Image size 1240x1240; wide-field fundus photograph of an infant — 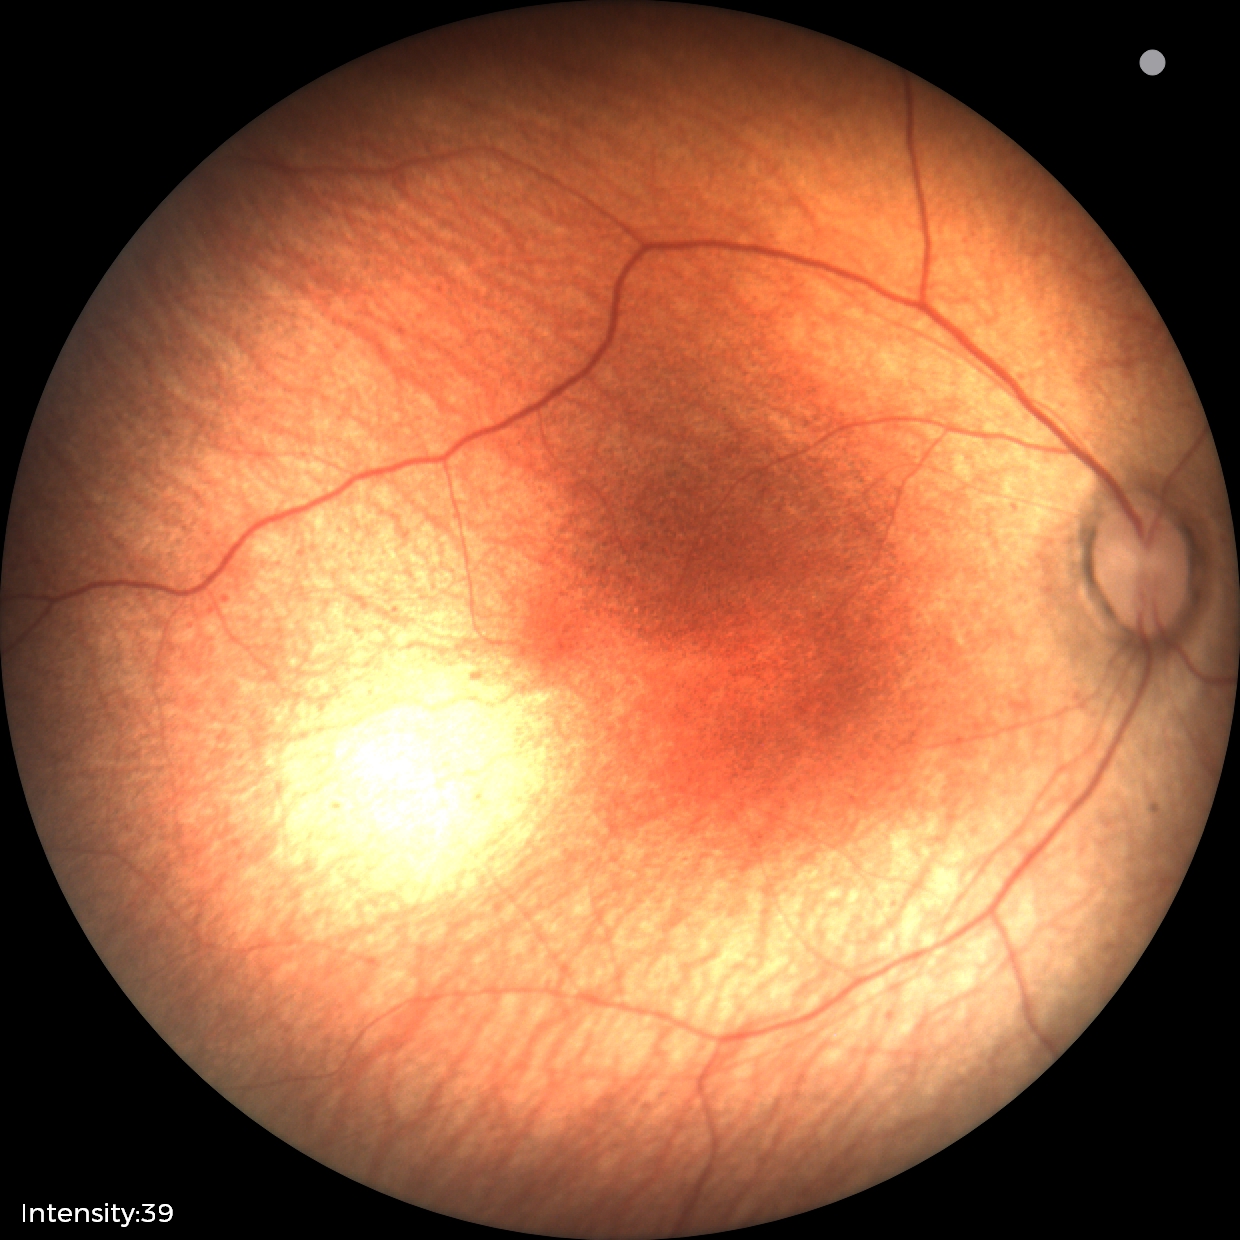

Examination with physiological retinal findings.